Without pupil dilation
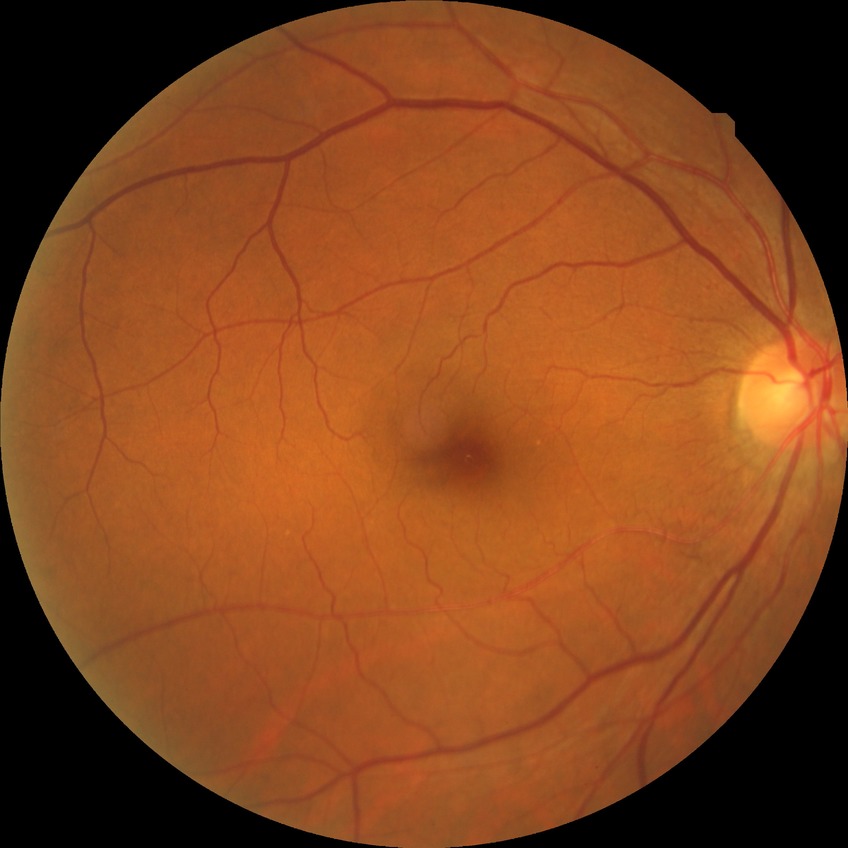
  davis_grade: no diabetic retinopathy